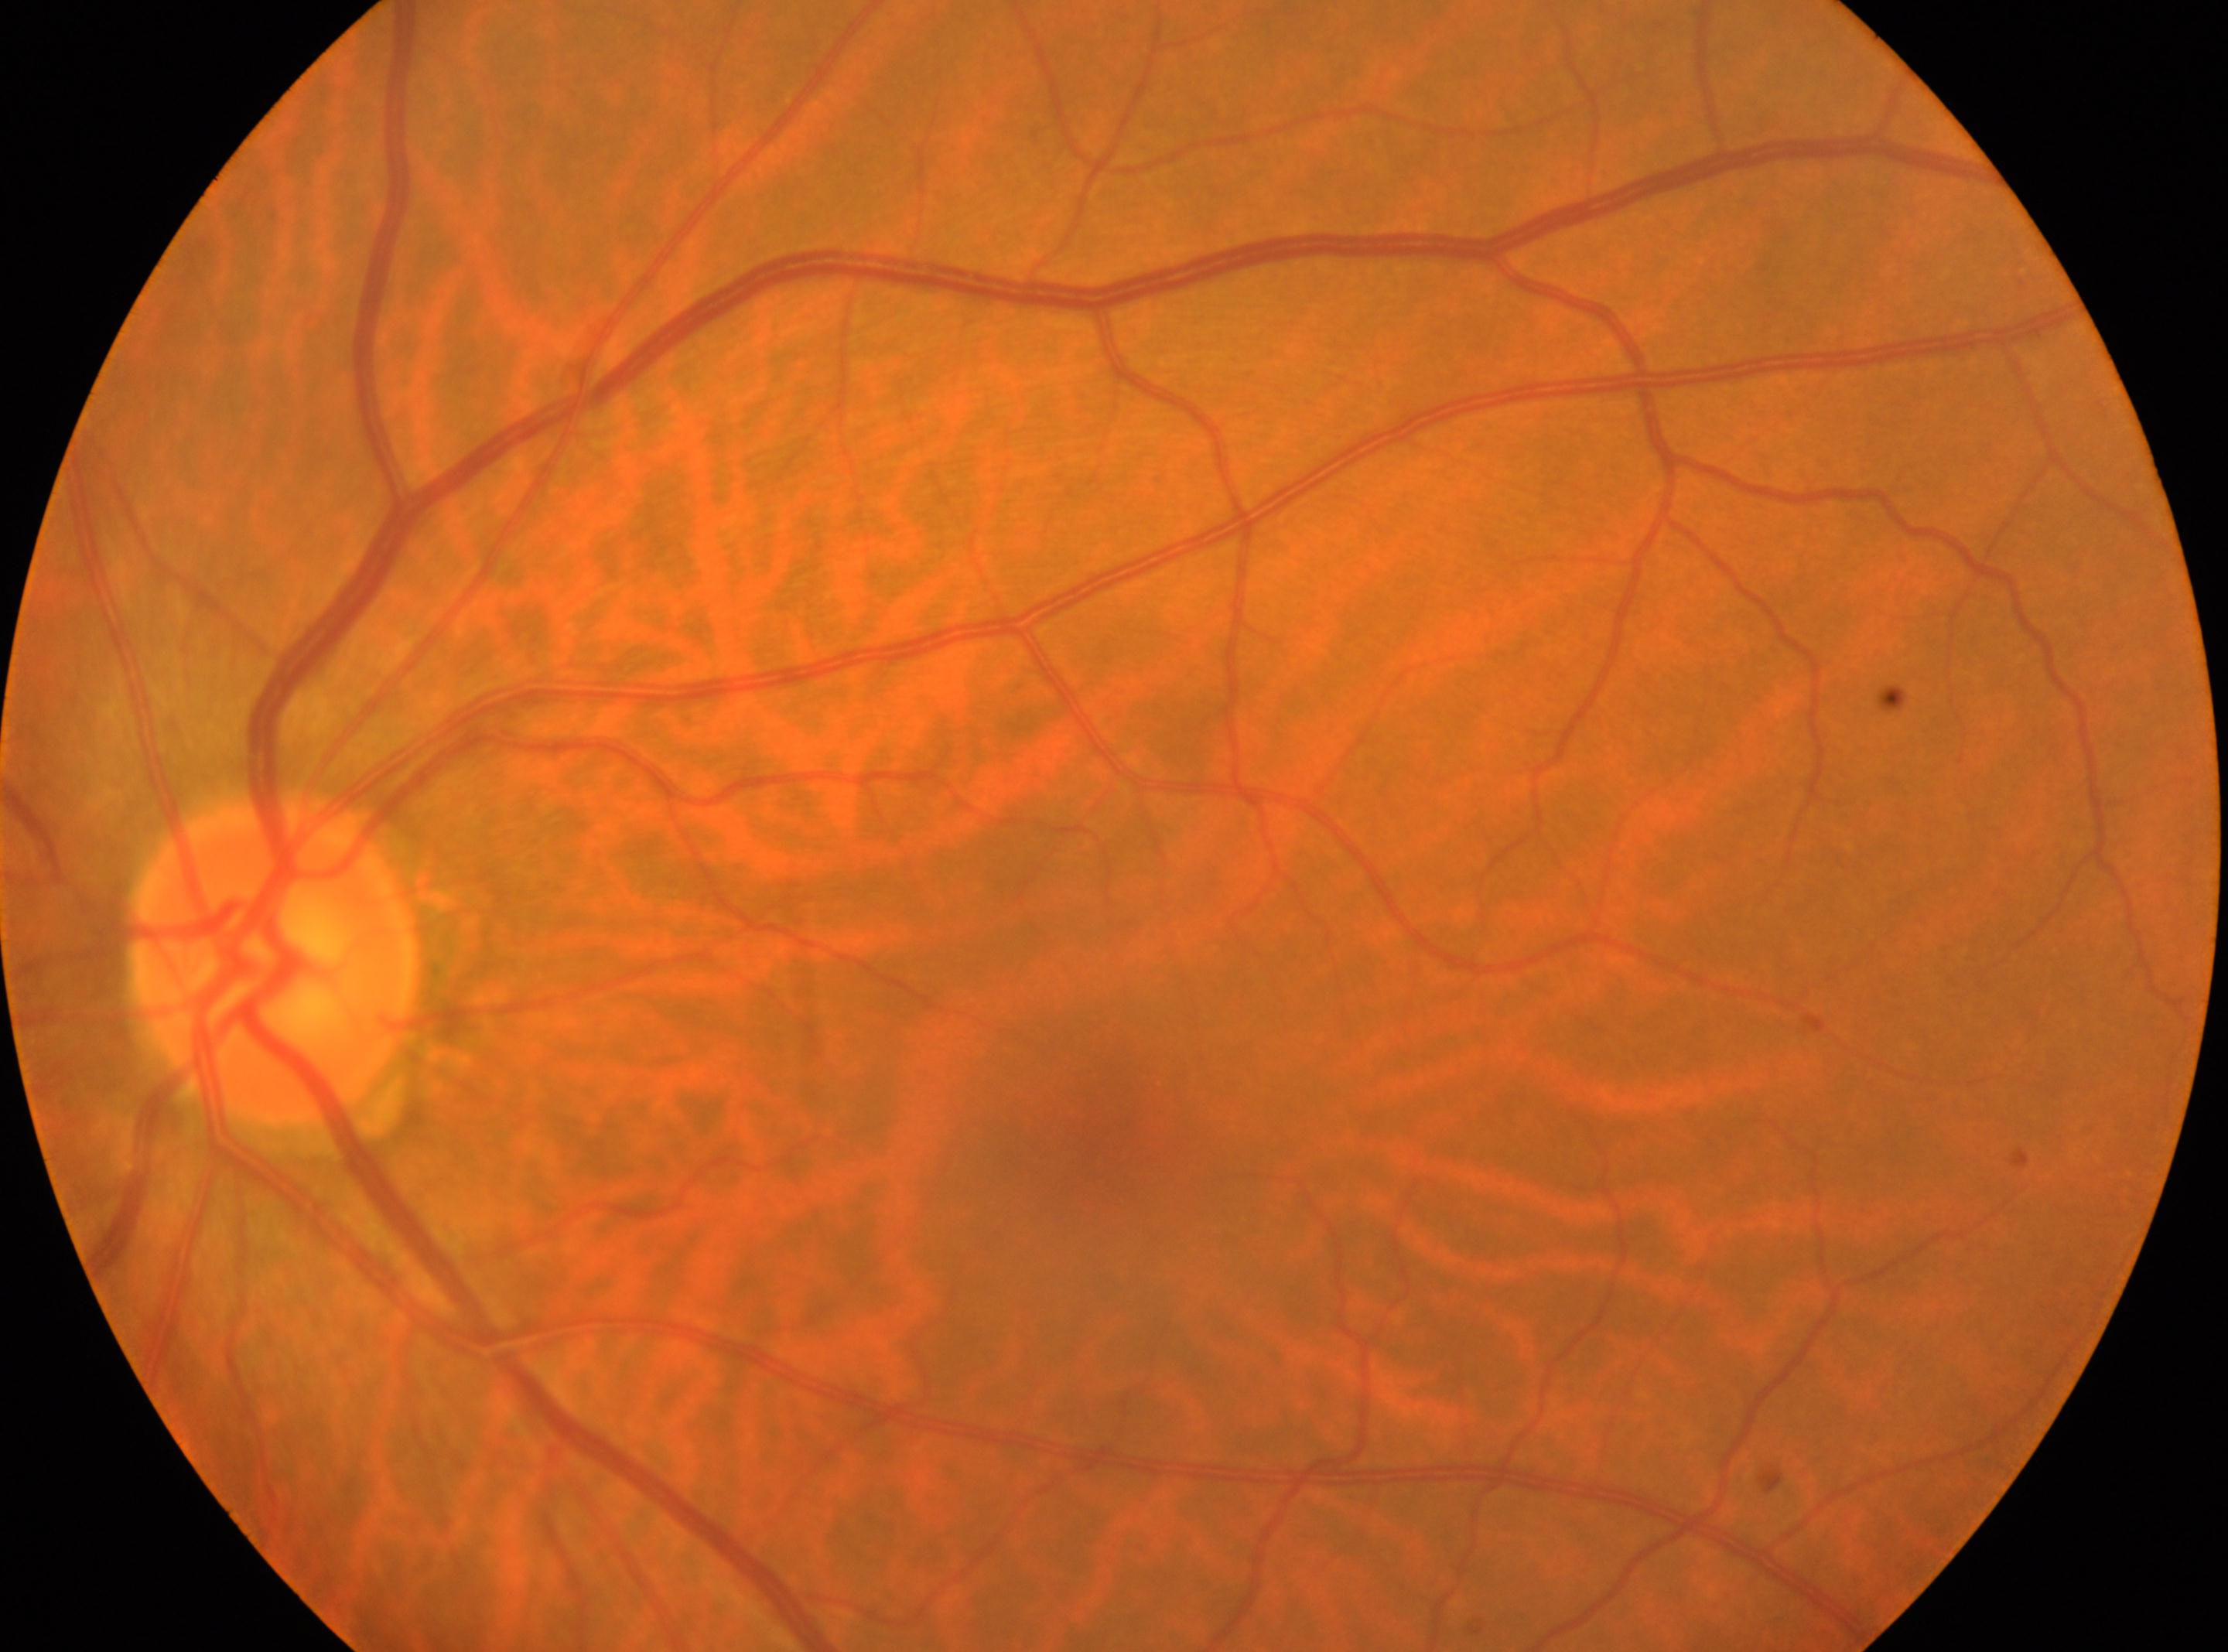

The optic nerve head is at (274, 957).
Retinopathy is grade 0 (no apparent retinopathy).
Eye: the left eye.
The fovea center is at (1100, 1129).
No diabetic retinopathy identified.